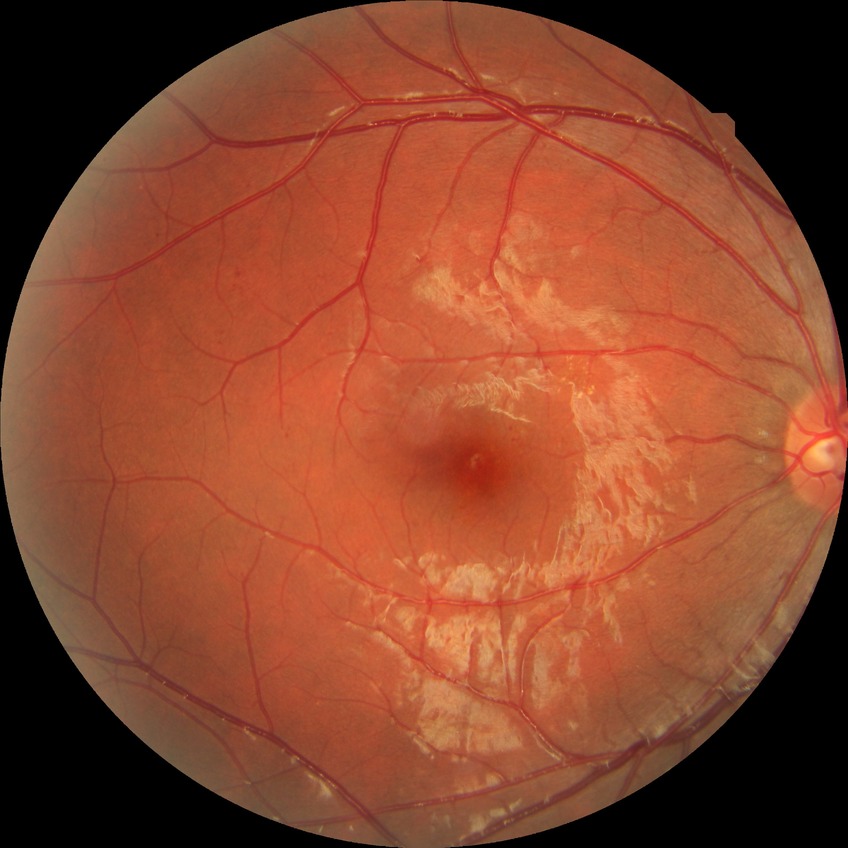 Modified Davis grading: simple diabetic retinopathy.